1240x1240px. Camera: Phoenix ICON (100° FOV). Wide-field fundus photograph of an infant — 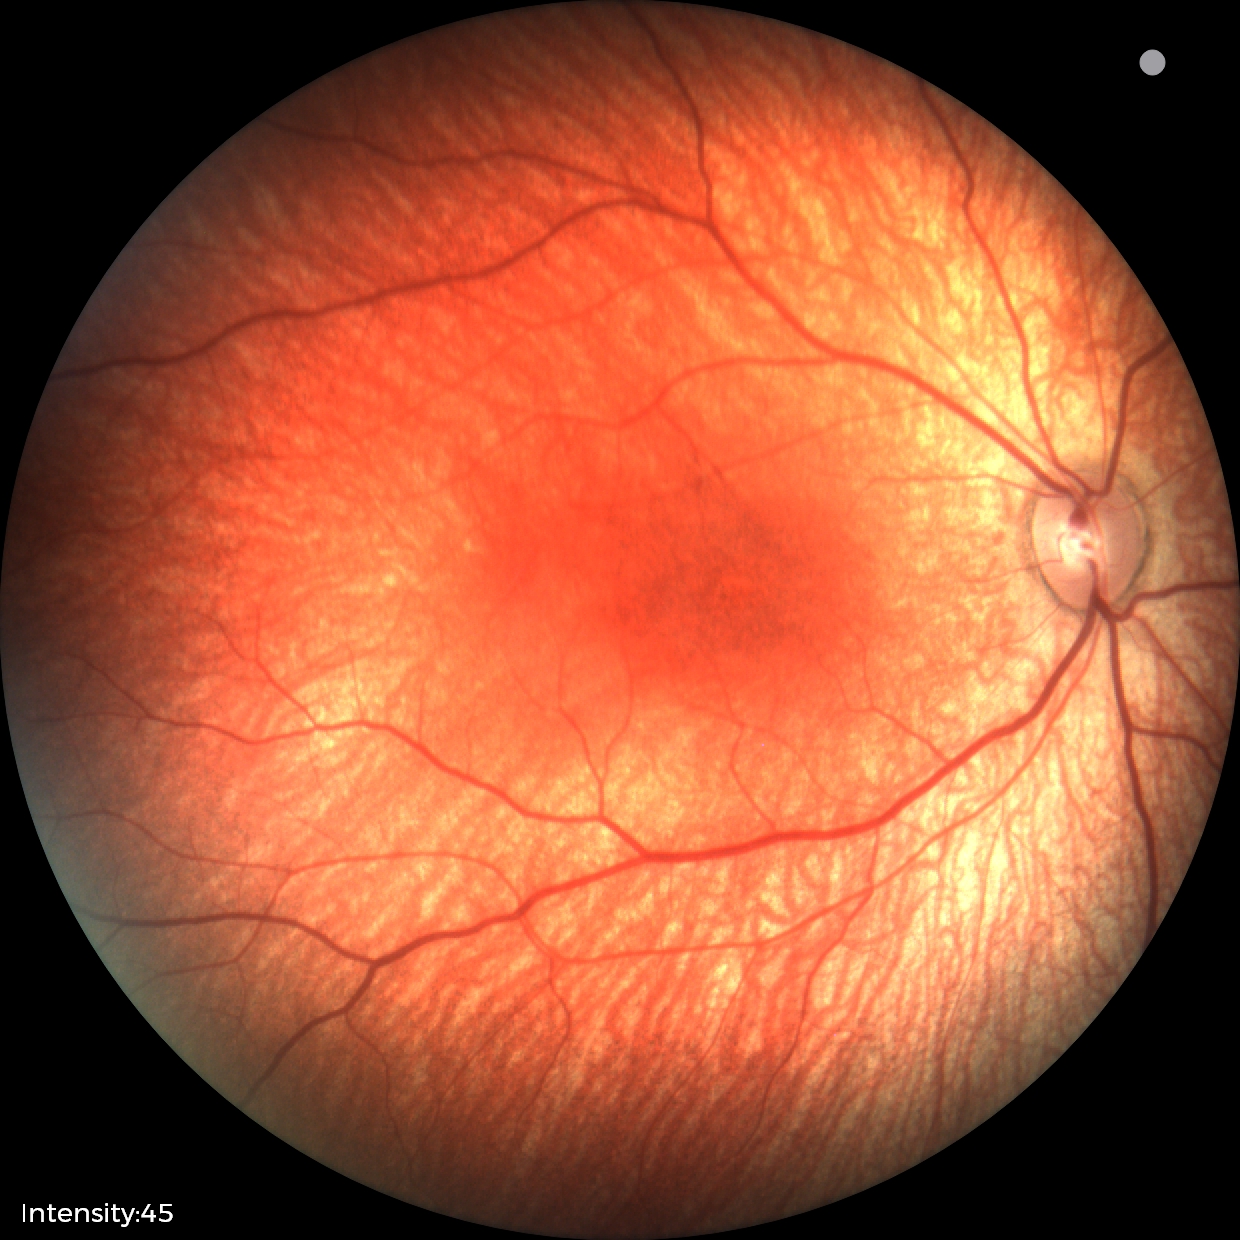

Physiological retinal appearance for postconceptual age.